CFP.
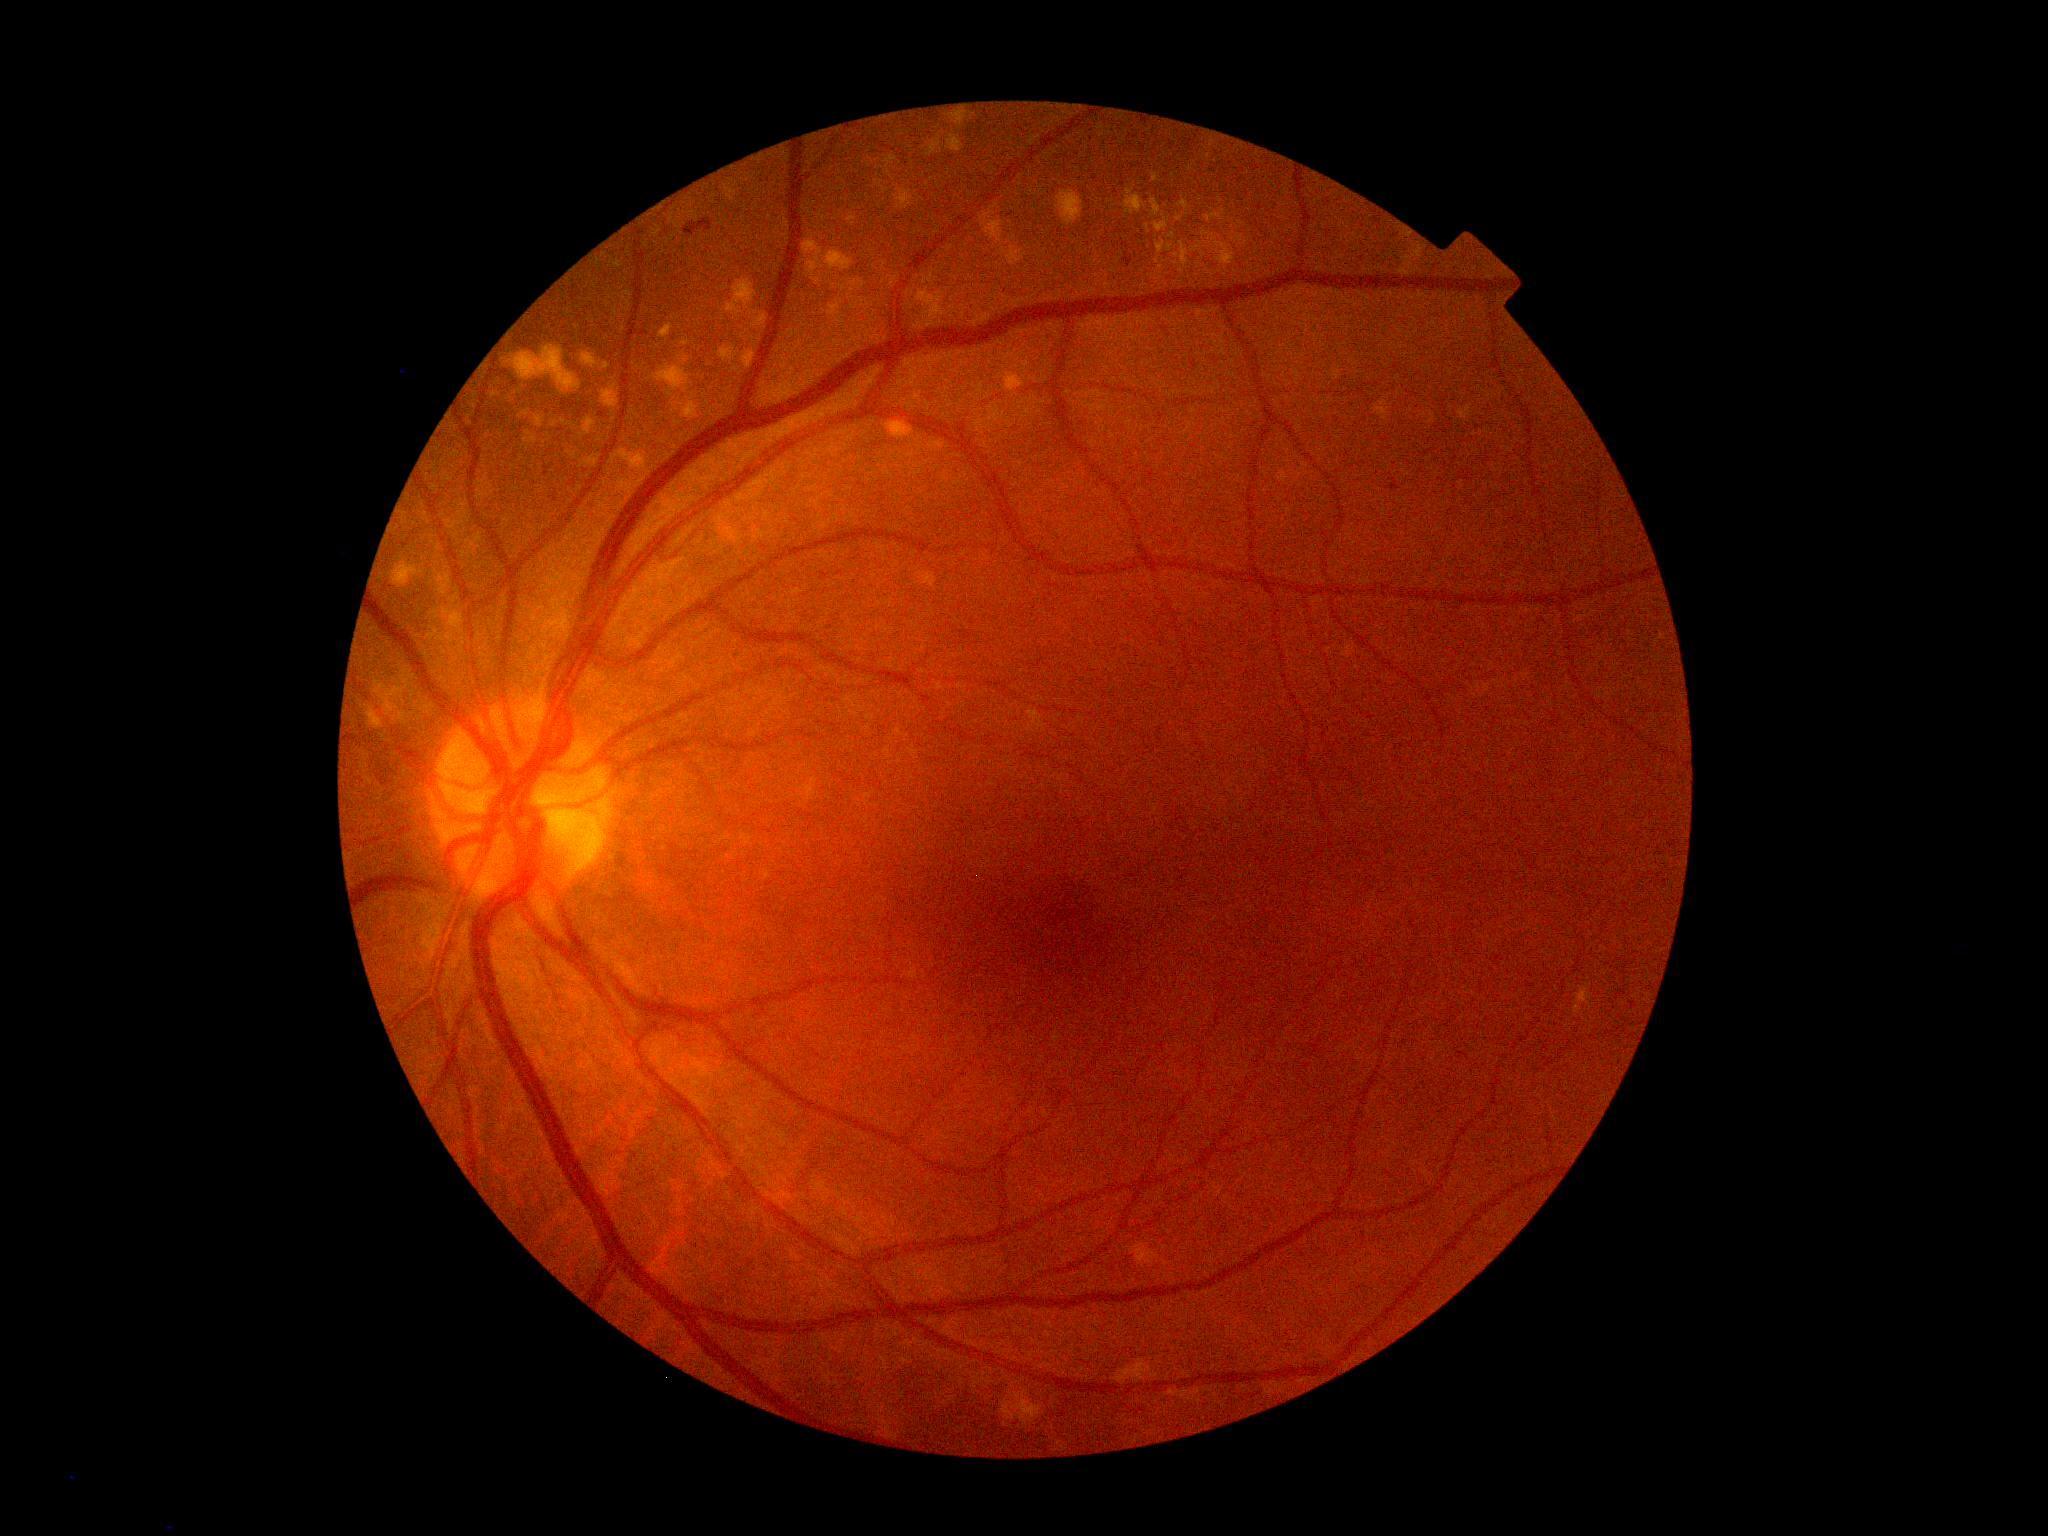 Diabetic retinopathy (DR): moderate NPDR (grade 2).